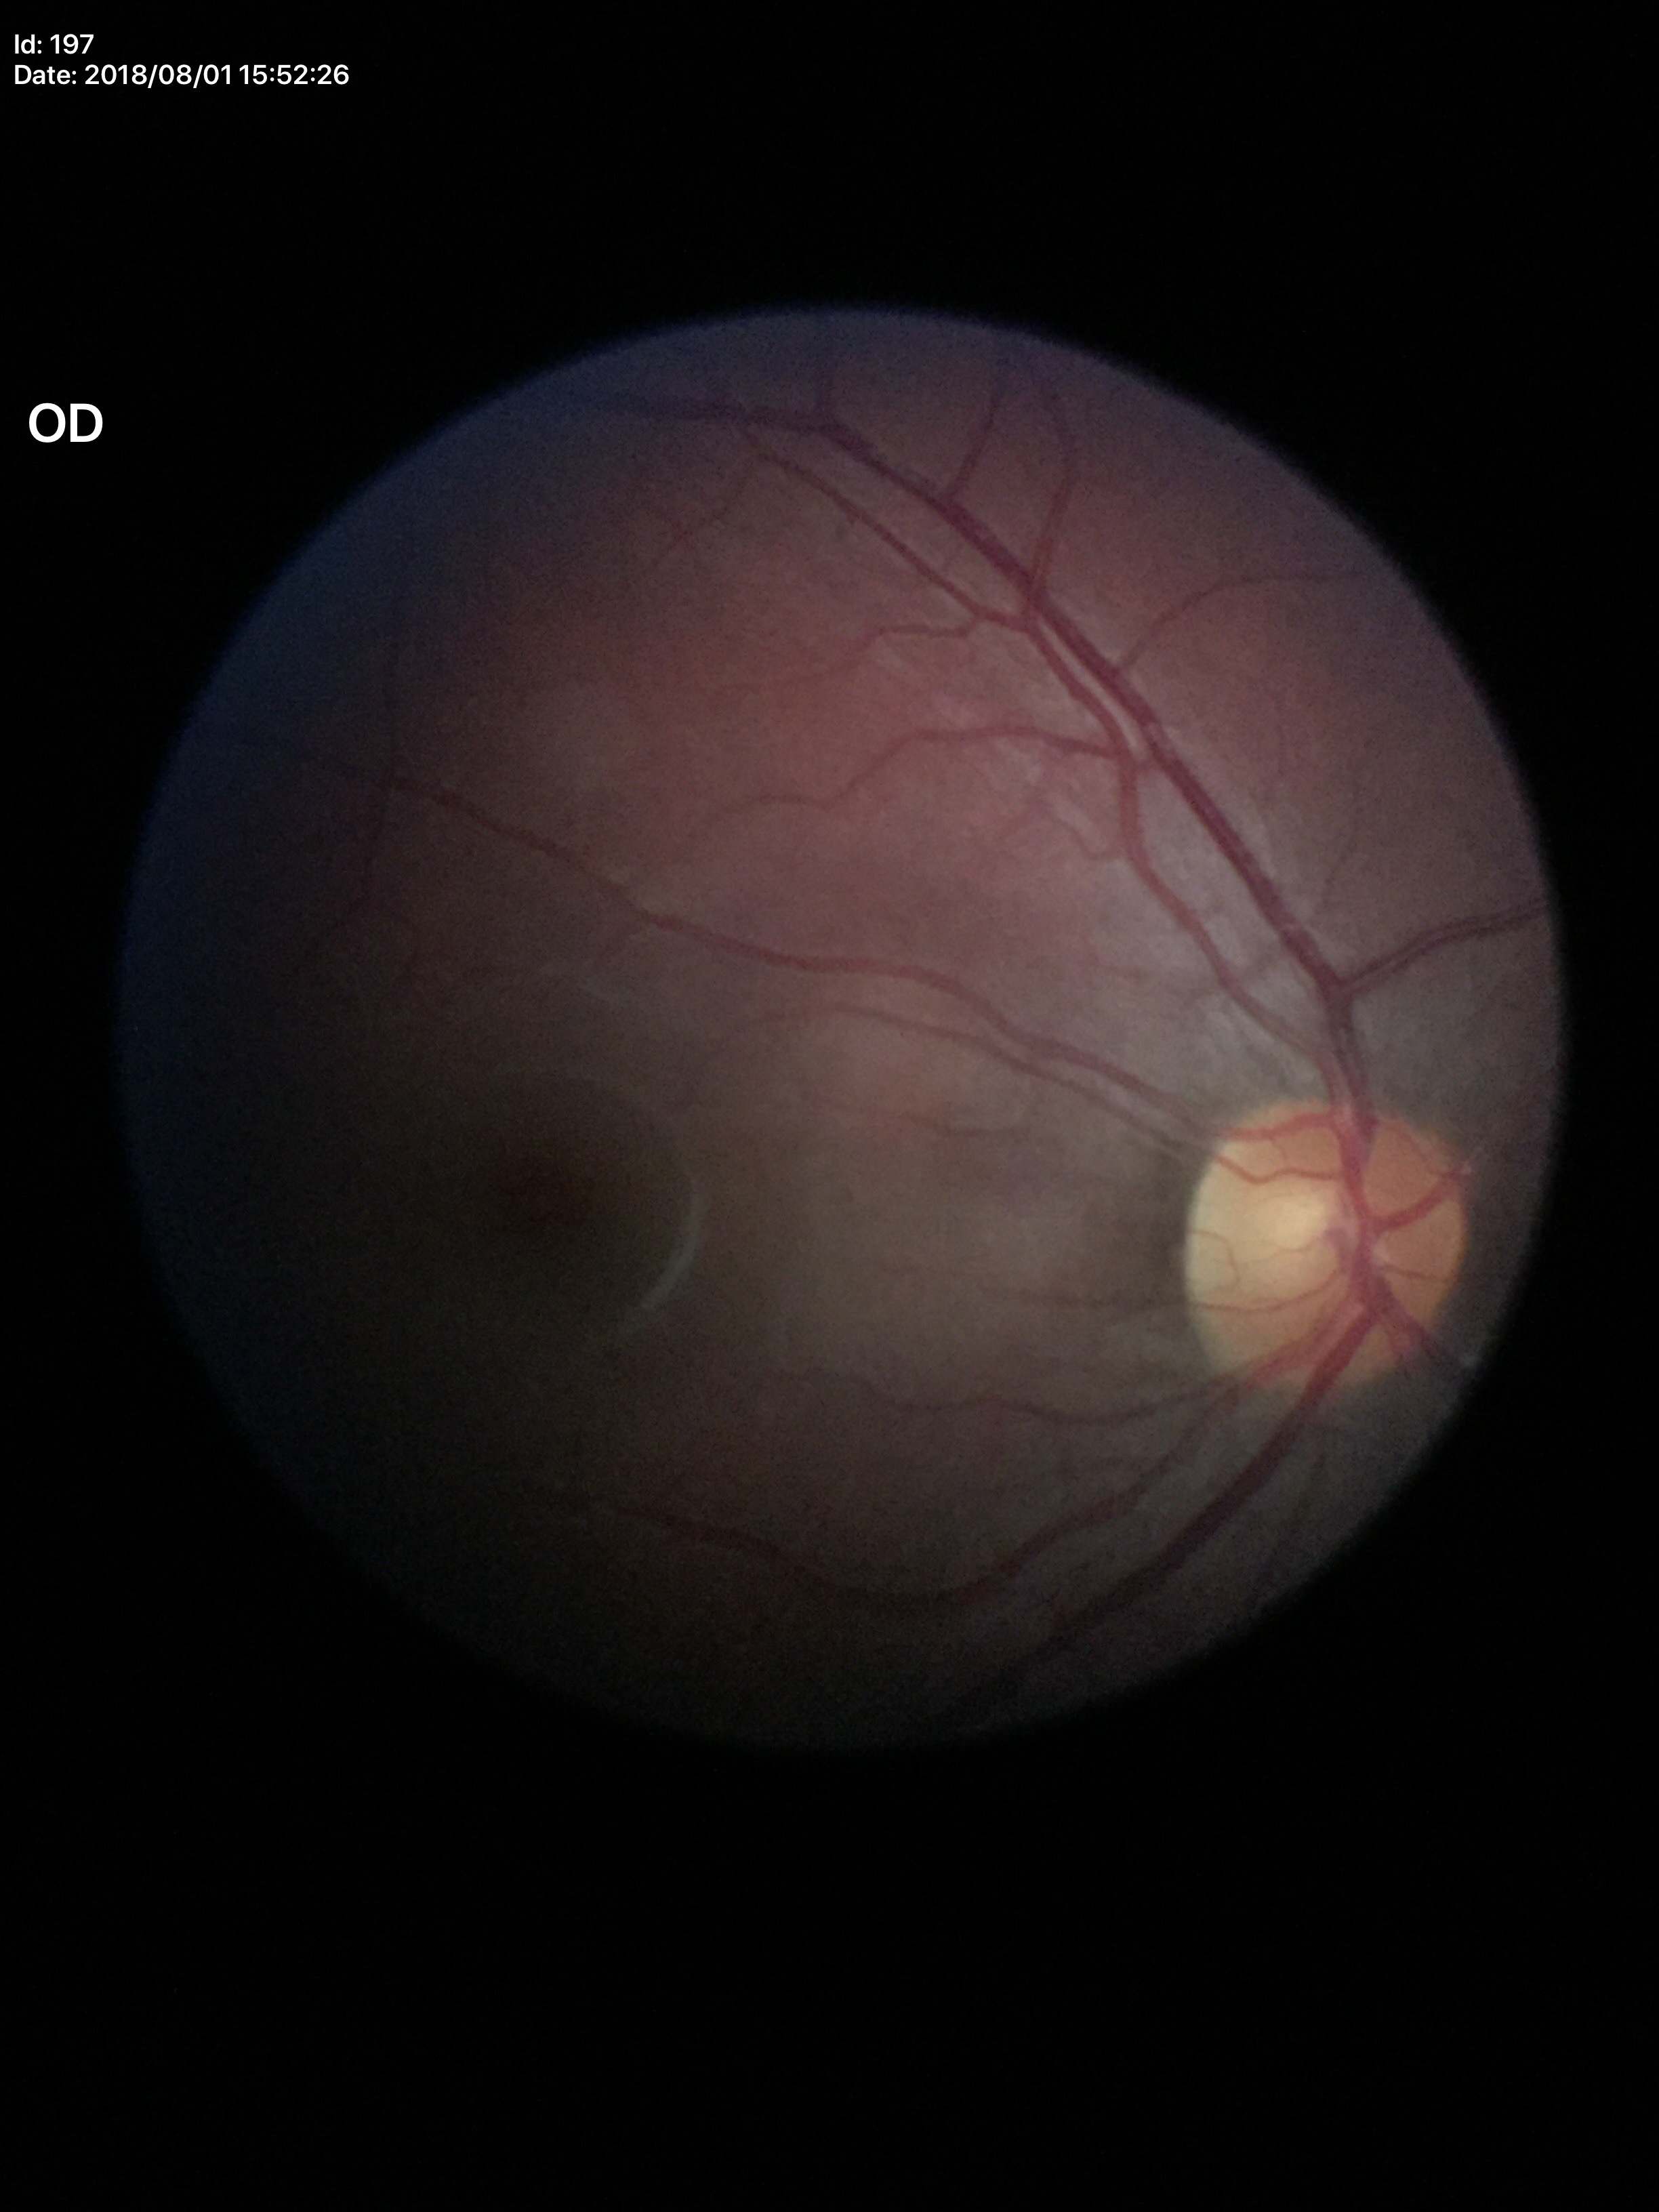

Glaucoma screening impression = no suspicious findings, vertical cup-disc ratio = 0.51.